50° field of view. Mydriatic (tropicamide and phenylephrine). Fundus photo. Posterior pole field covering the optic disc and macula.
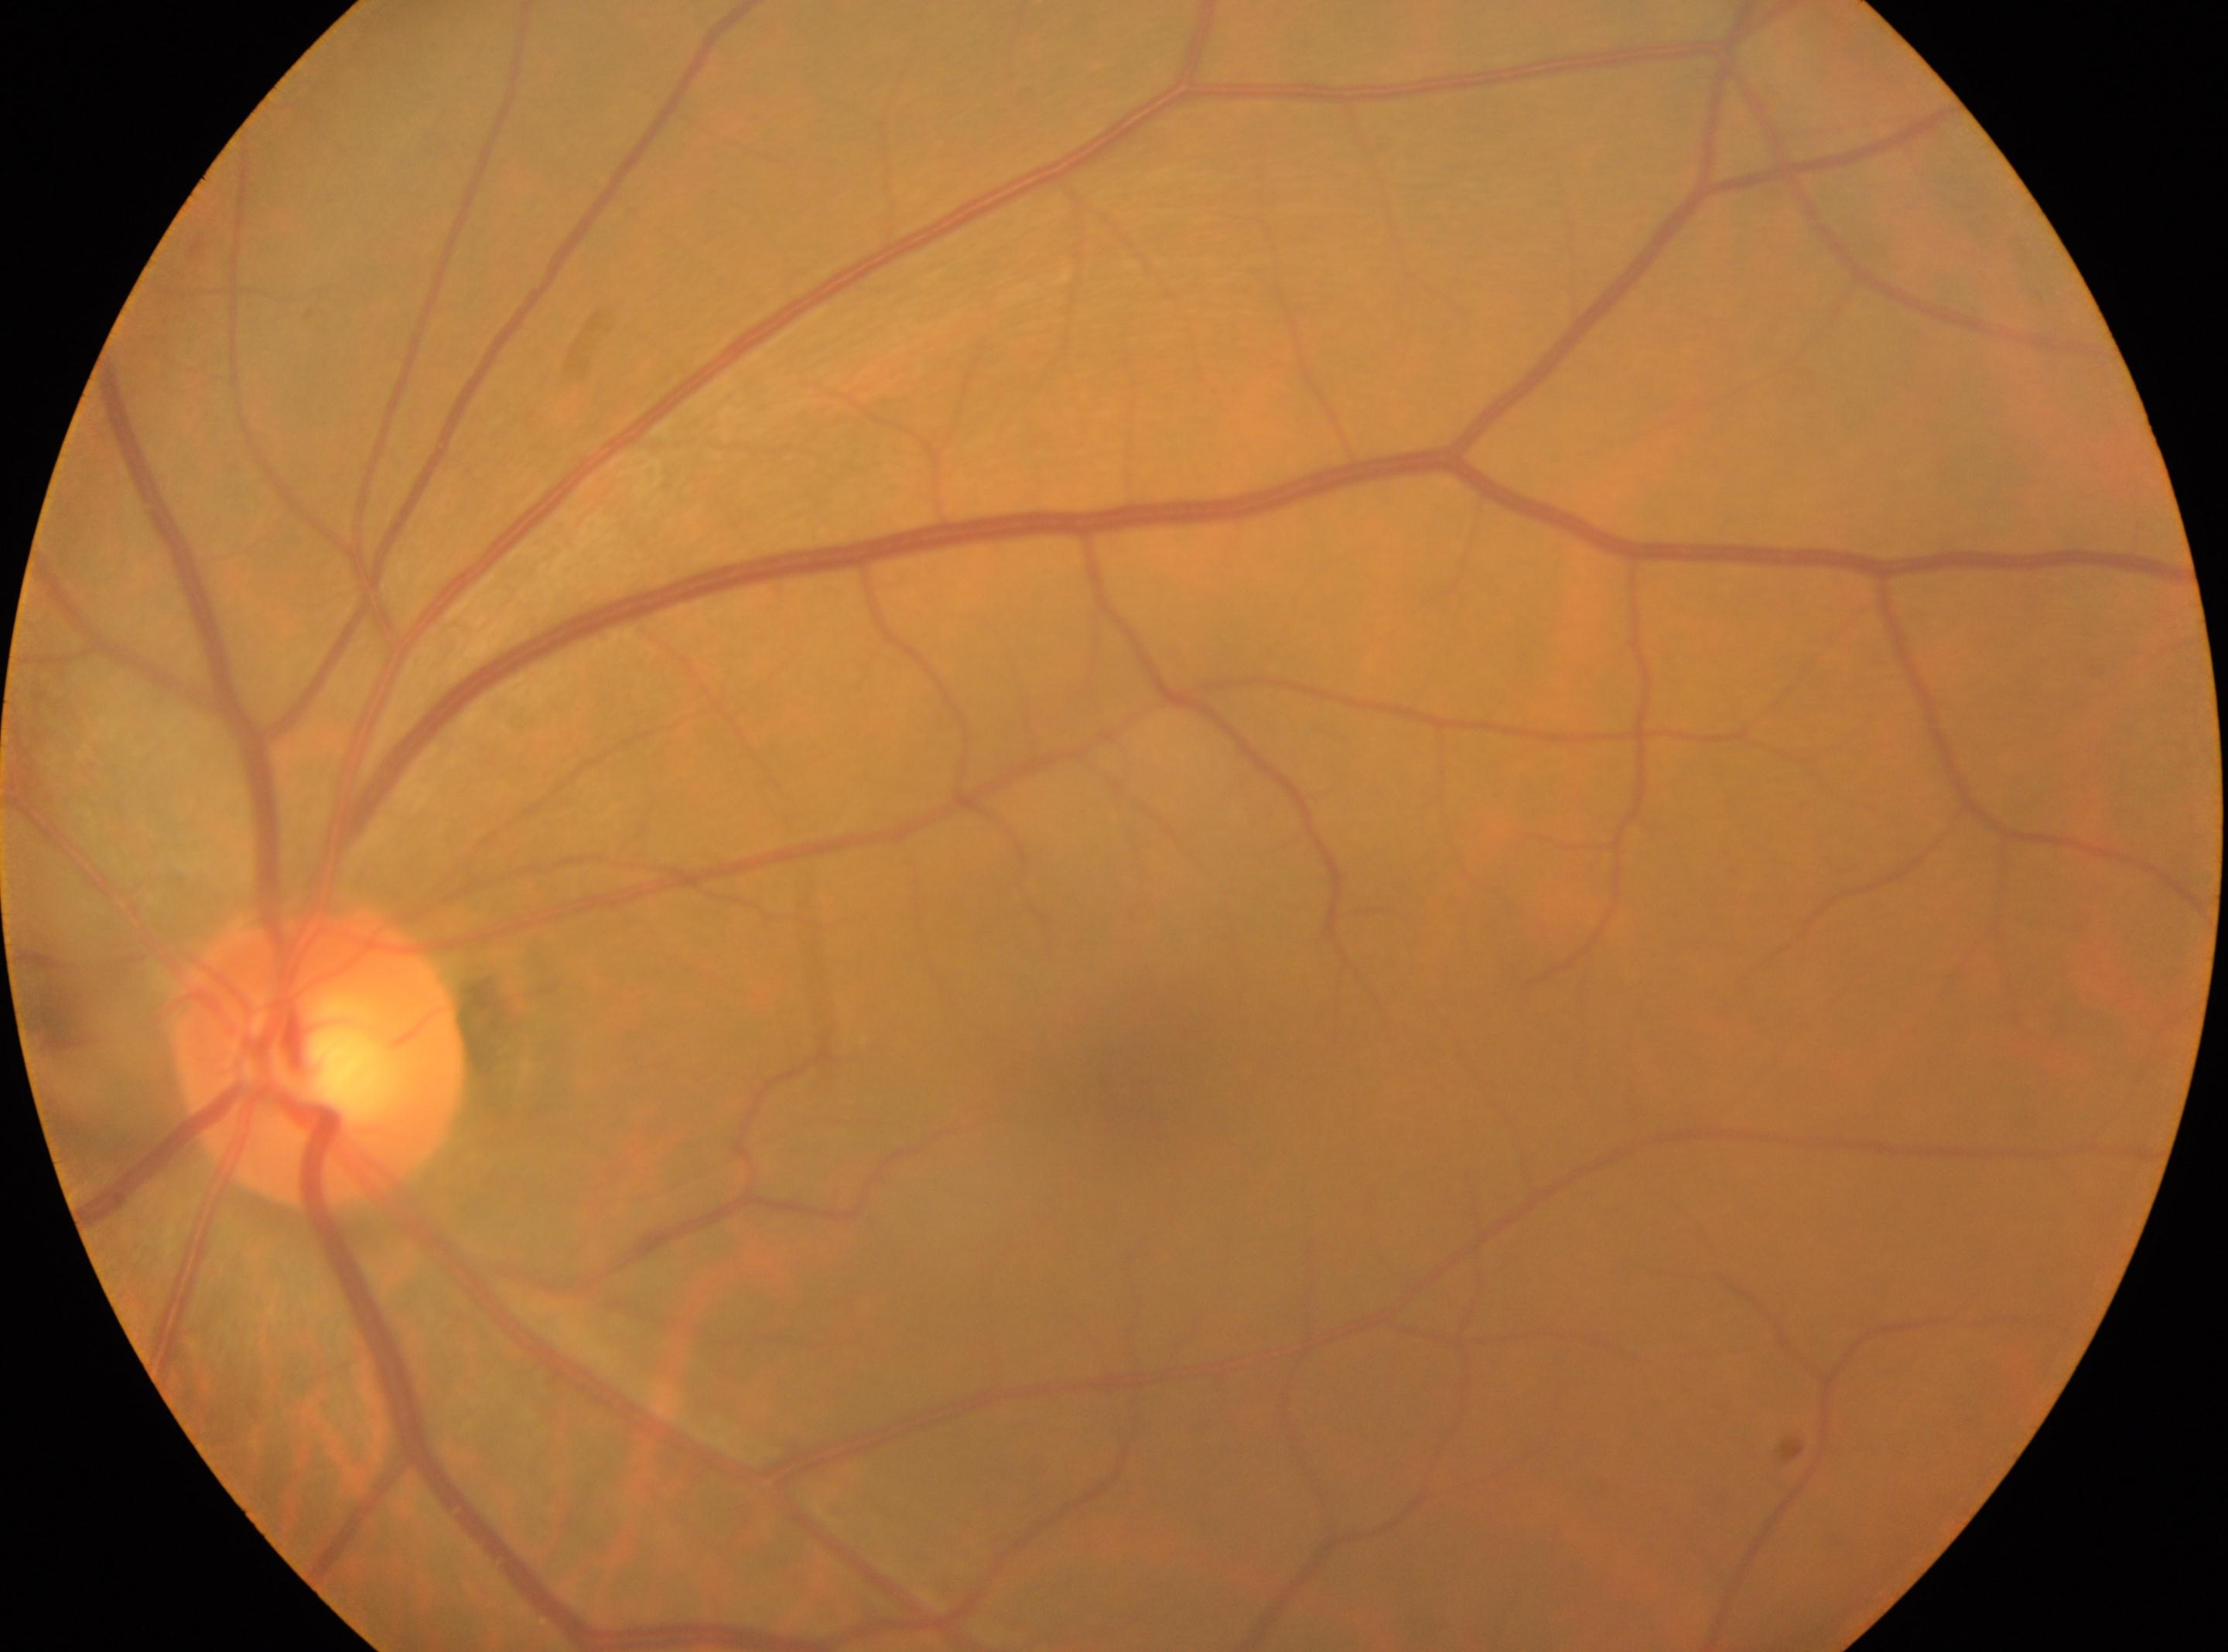 {"fovea": "[1133, 1080]", "eye": "the left eye", "dr_grade": "0", "optic_disc": "[320, 1055]"}